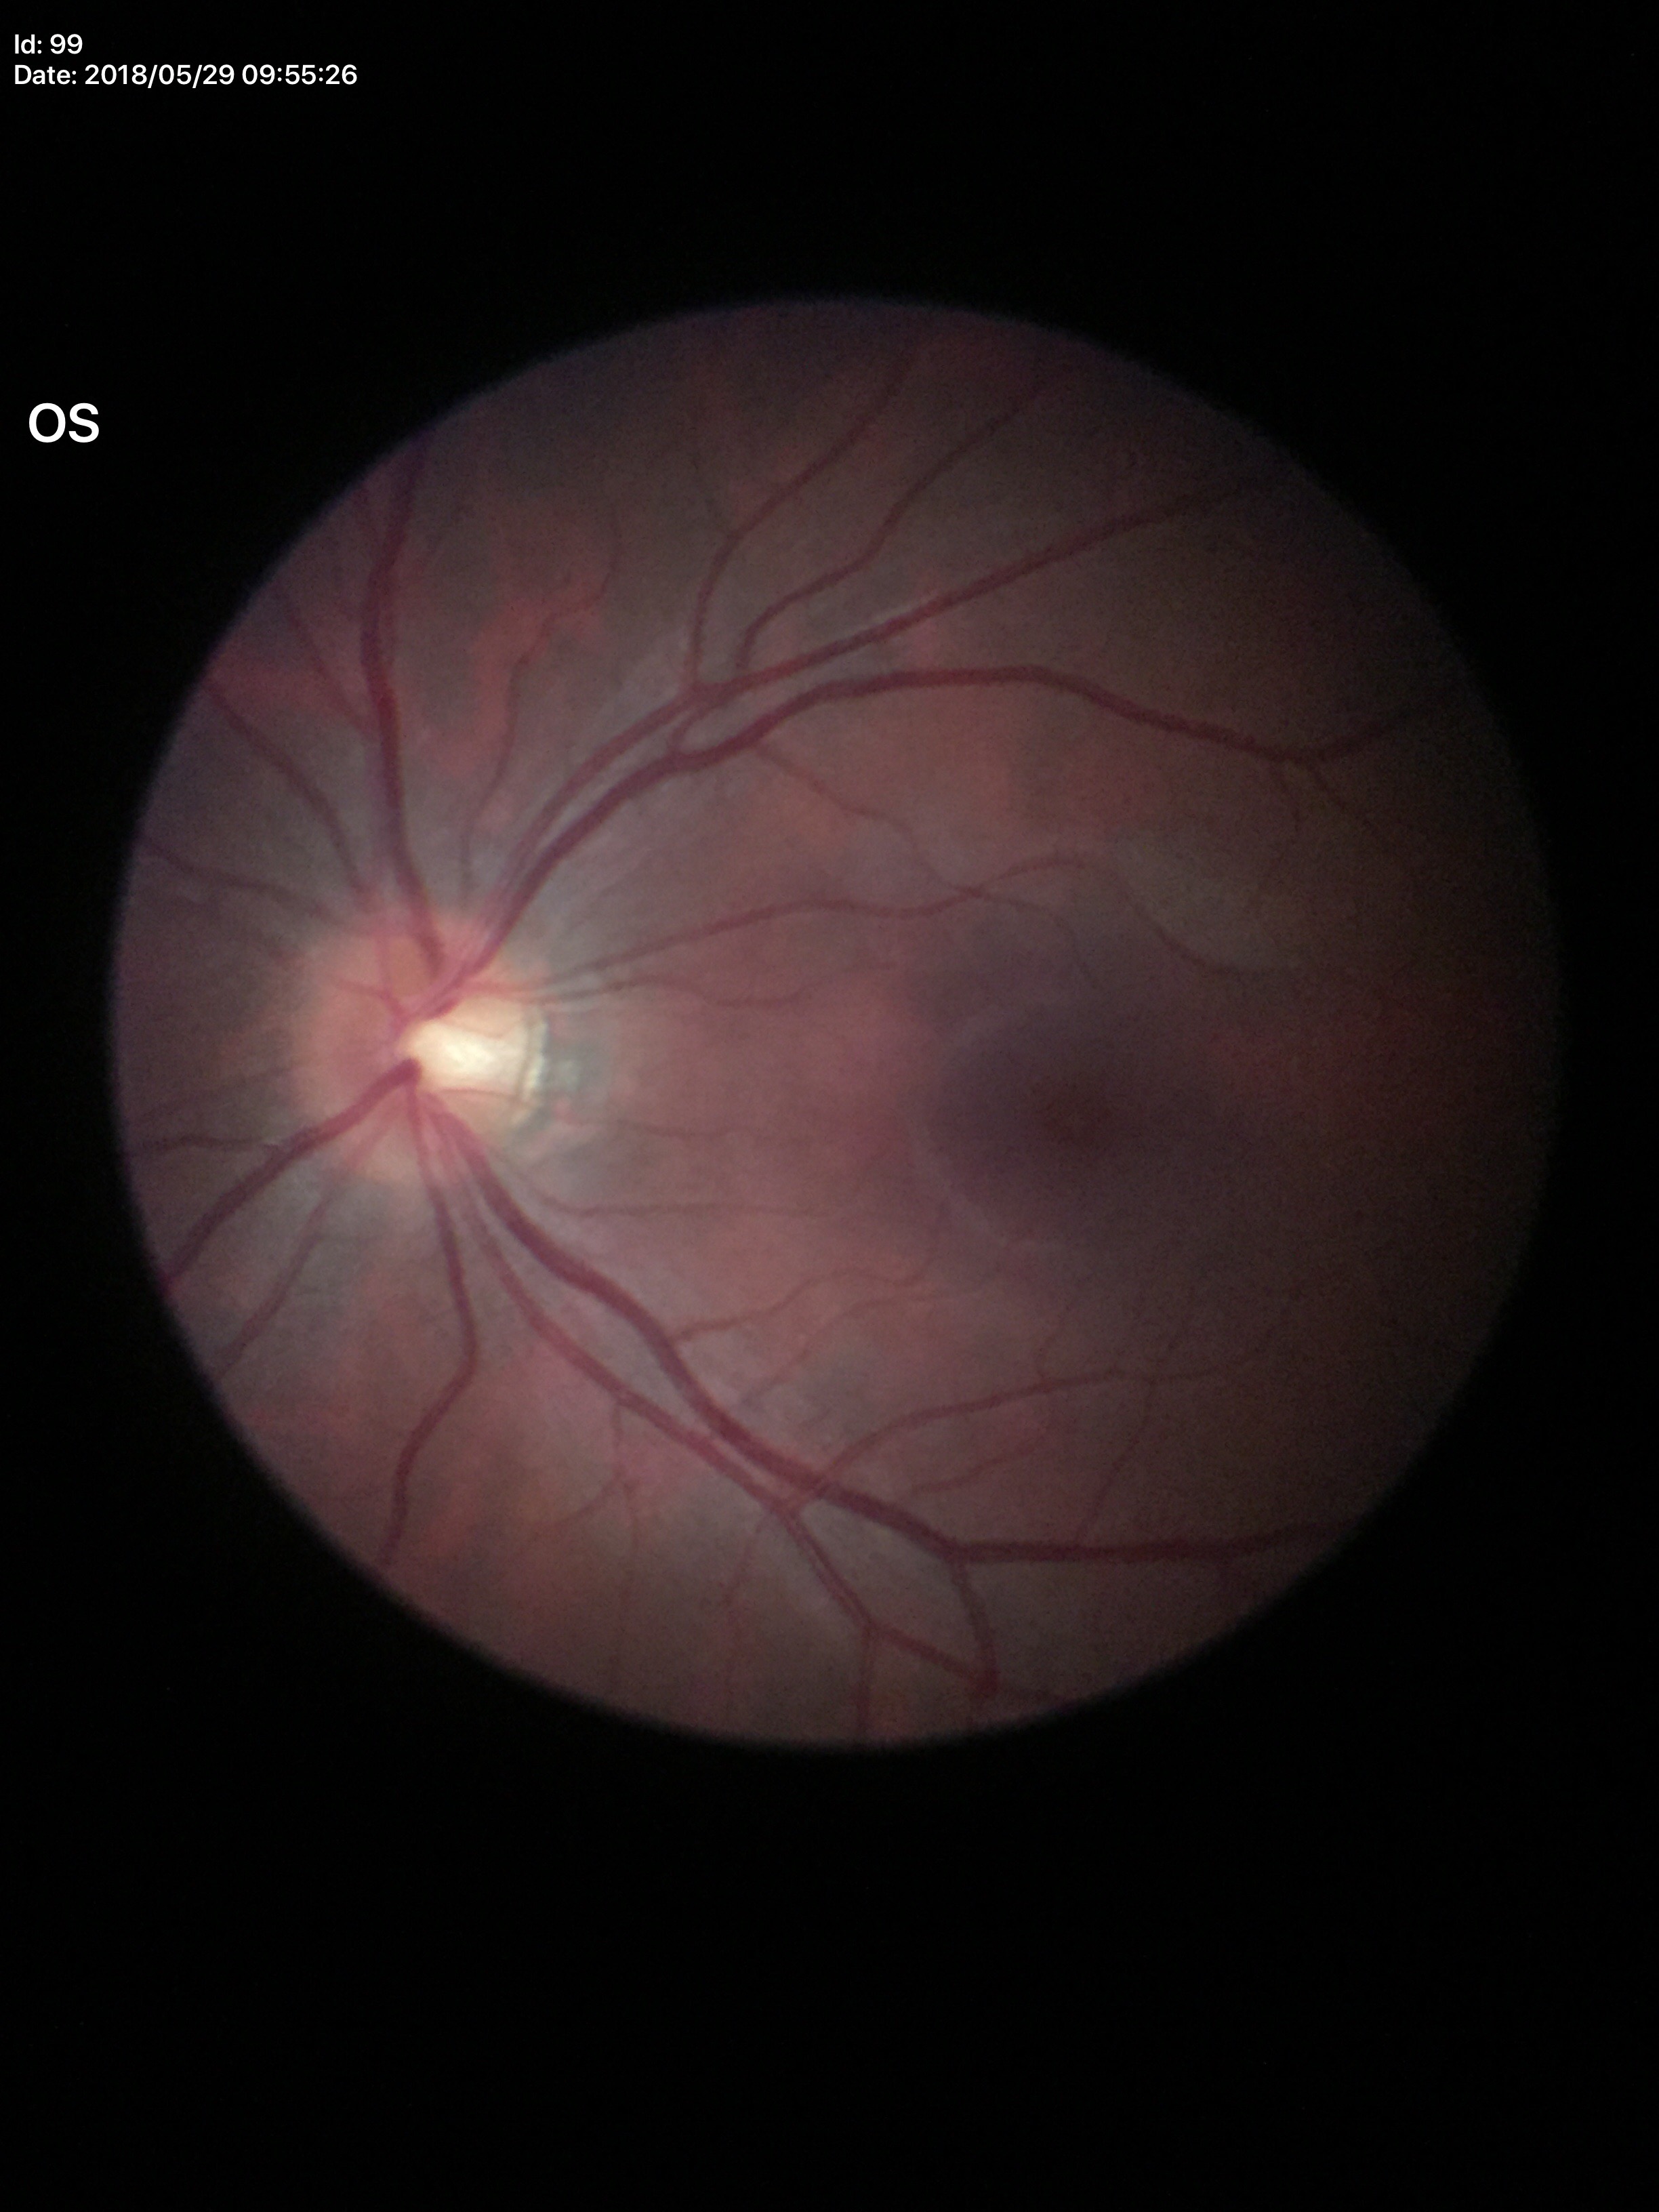

Findings:
- vertical cup-disc ratio (VCDR) · 0.55
- Glaucoma evaluation · negative